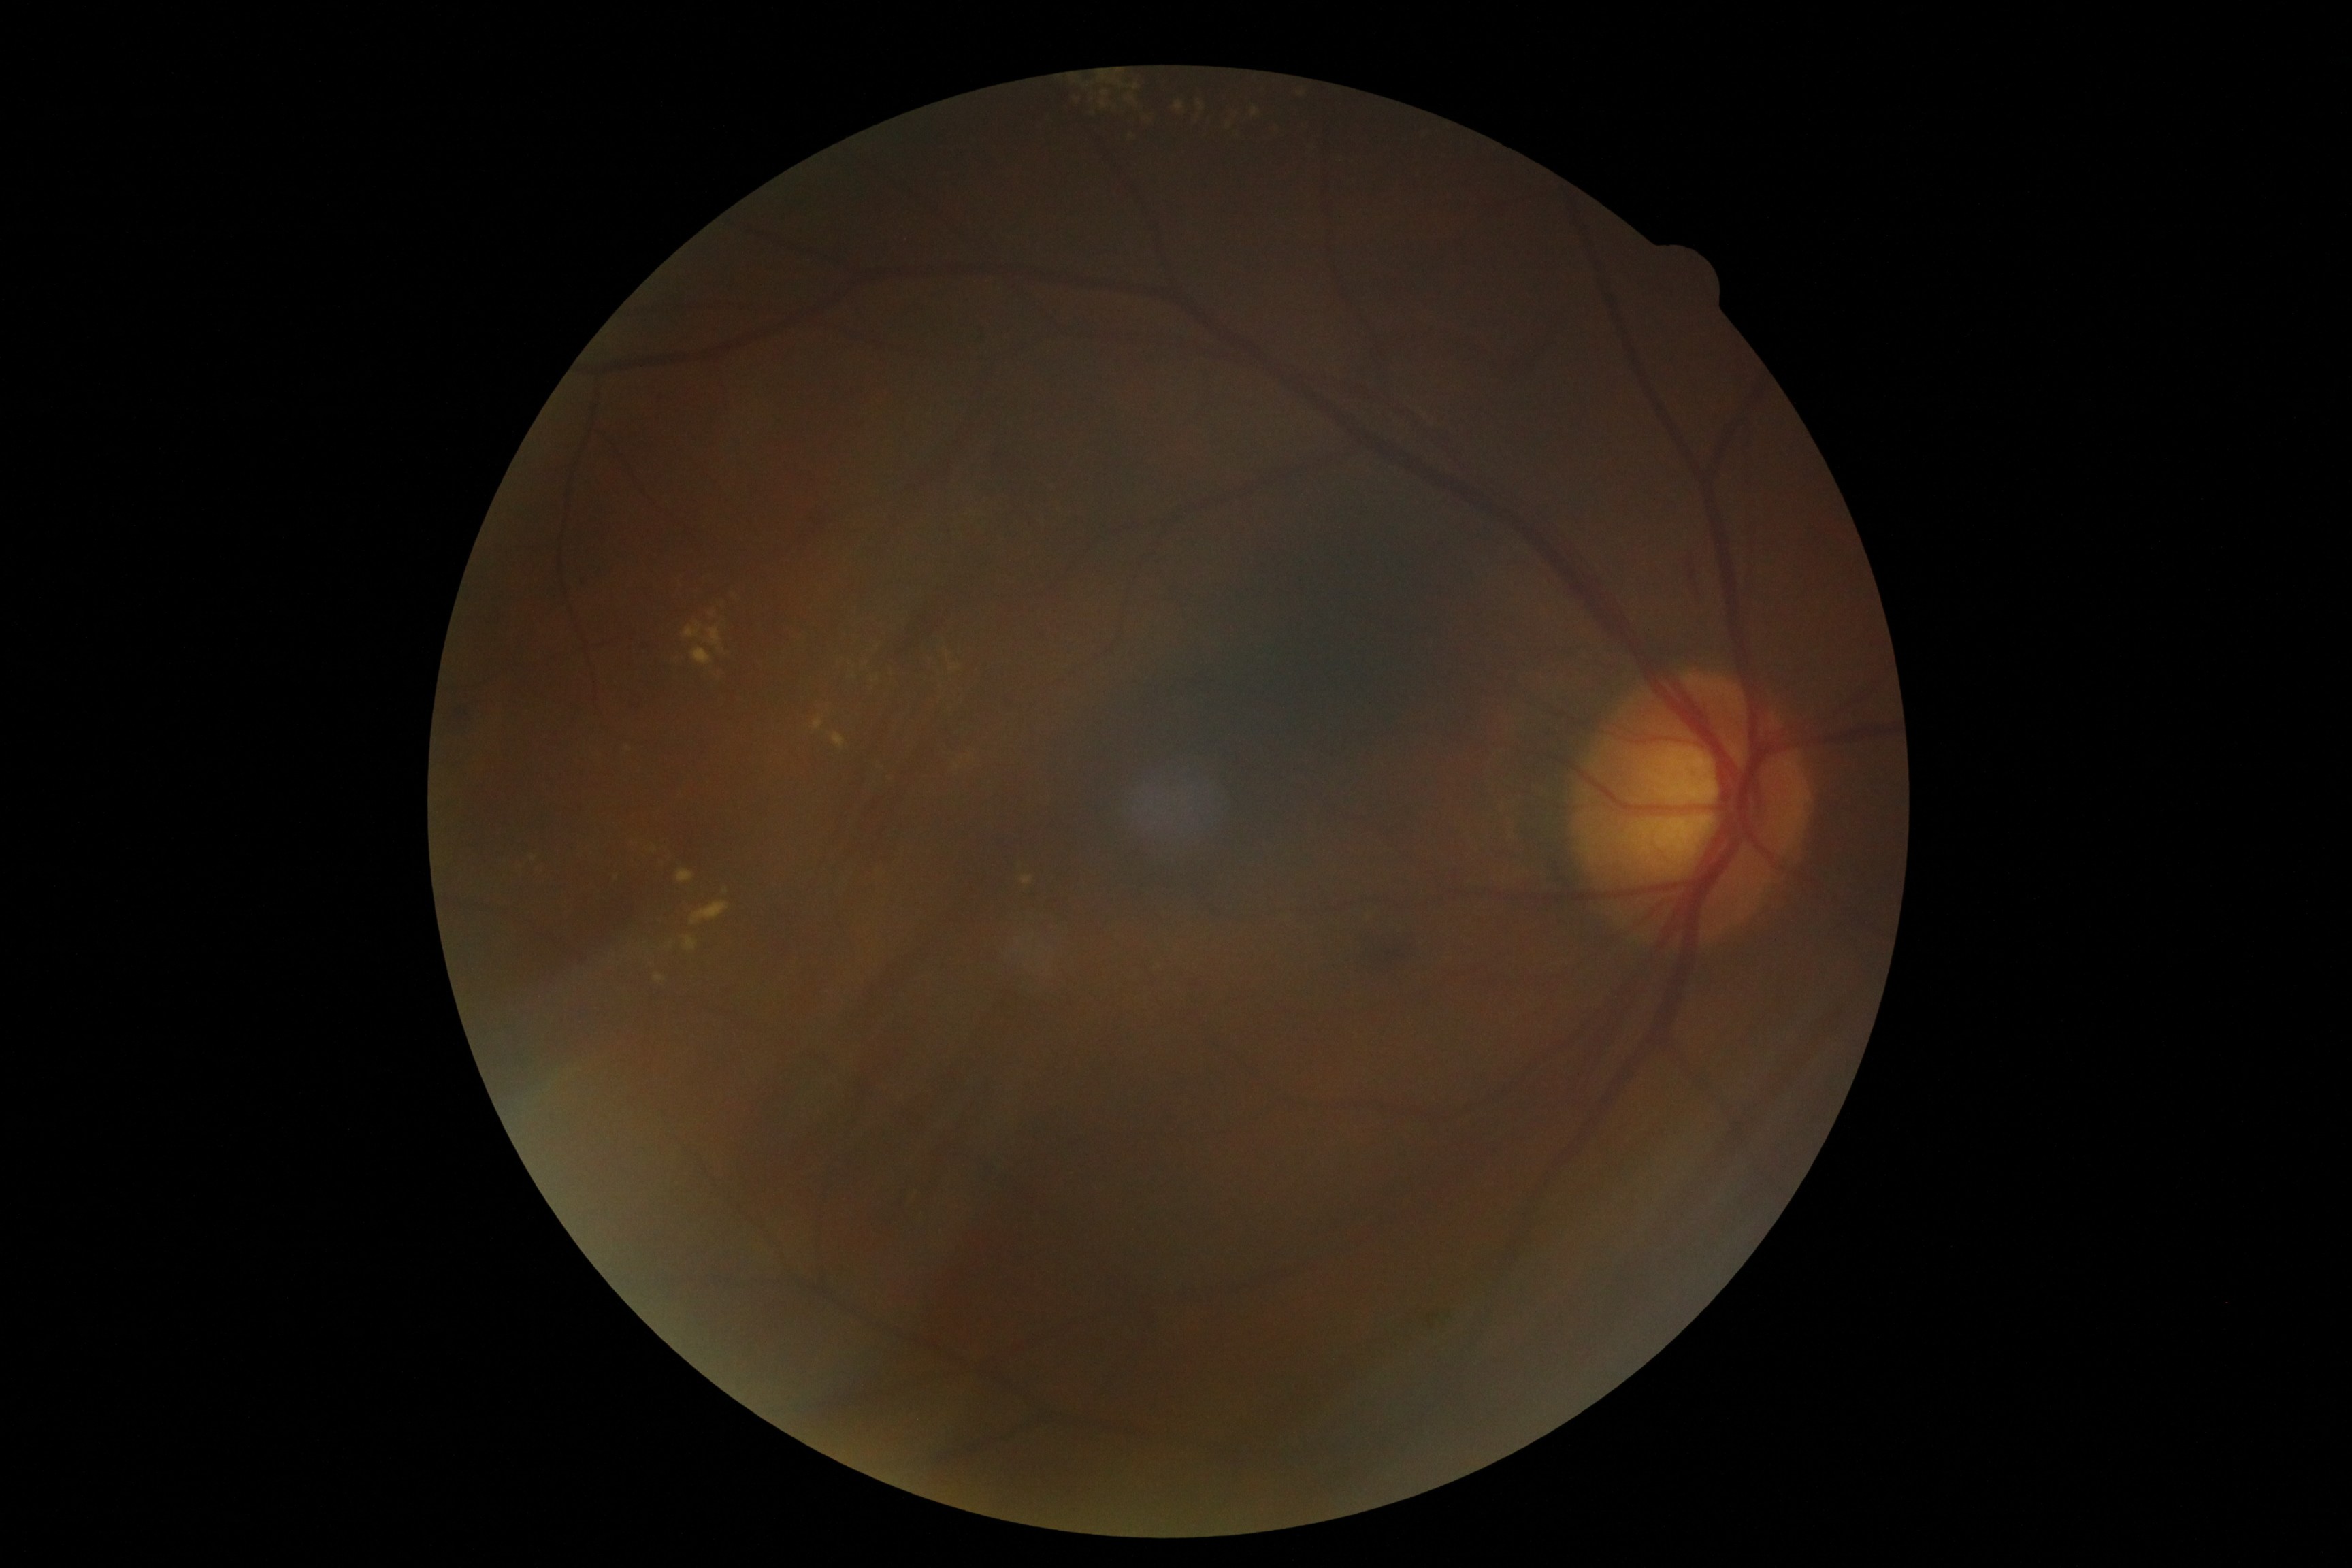
DR class: non-proliferative diabetic retinopathy; diabetic retinopathy severity: 2/4.